DR severity per modified Davis staging: 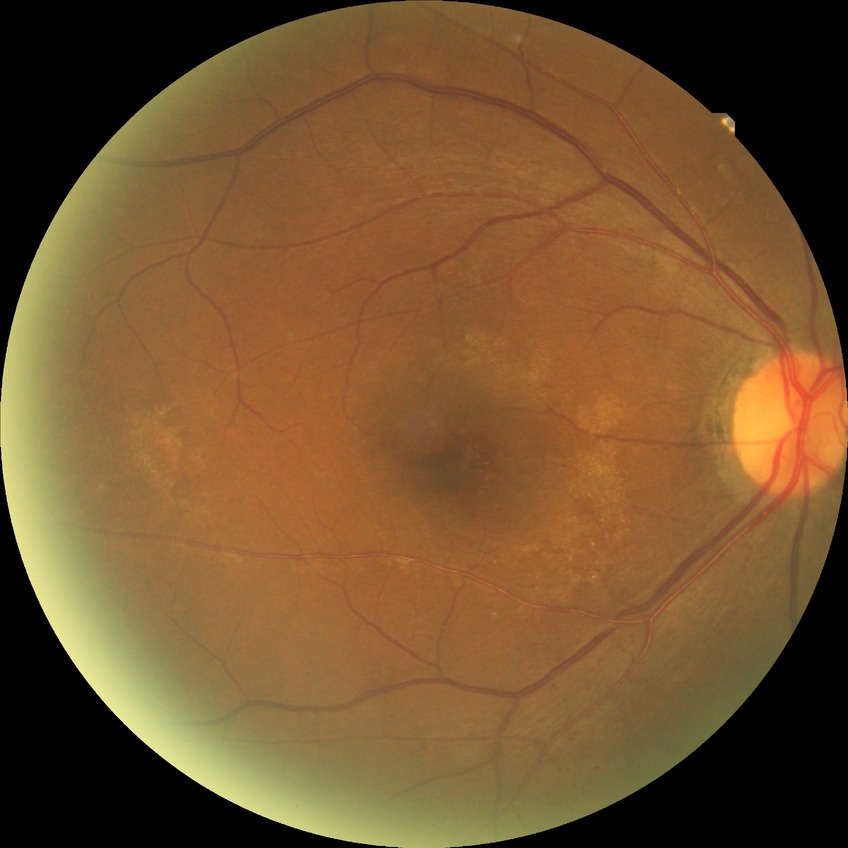
DR impression: no DR findings, DR severity: NDR.